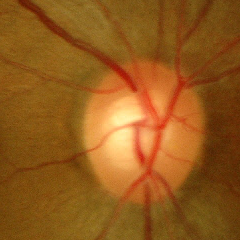
Diagnosis: no glaucomatous optic neuropathy.